45° FOV, NIDEK AFC-230 fundus camera, 848 by 848 pixels, nonmydriatic:
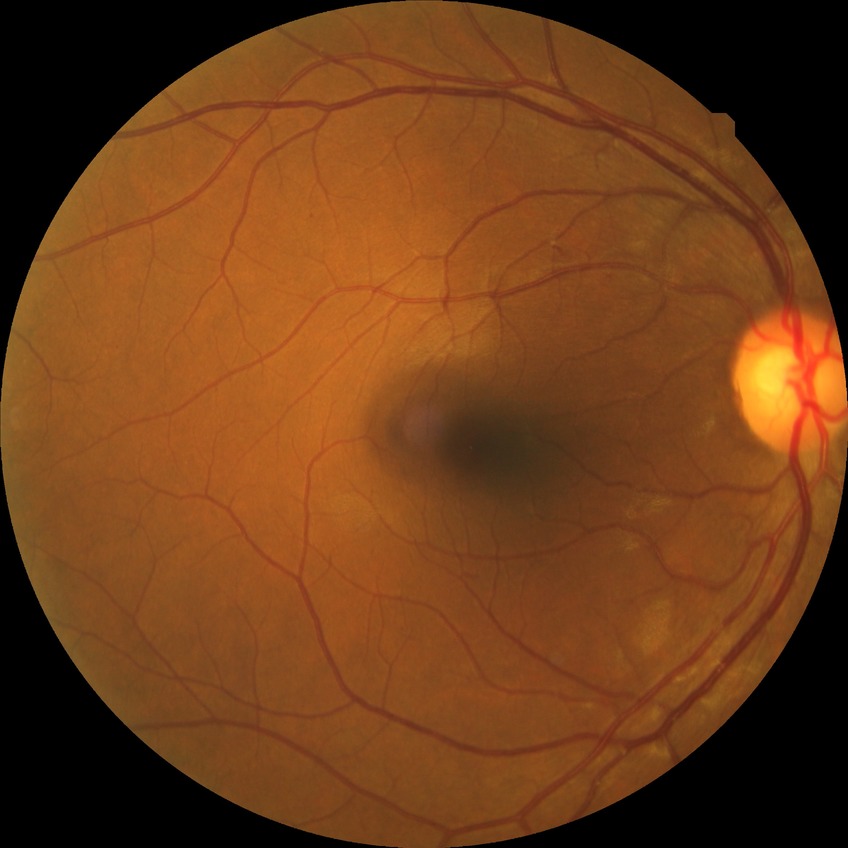 {
  "davis_grade": "no diabetic retinopathy (NDR)"
}